Wide-field fundus photograph of an infant:
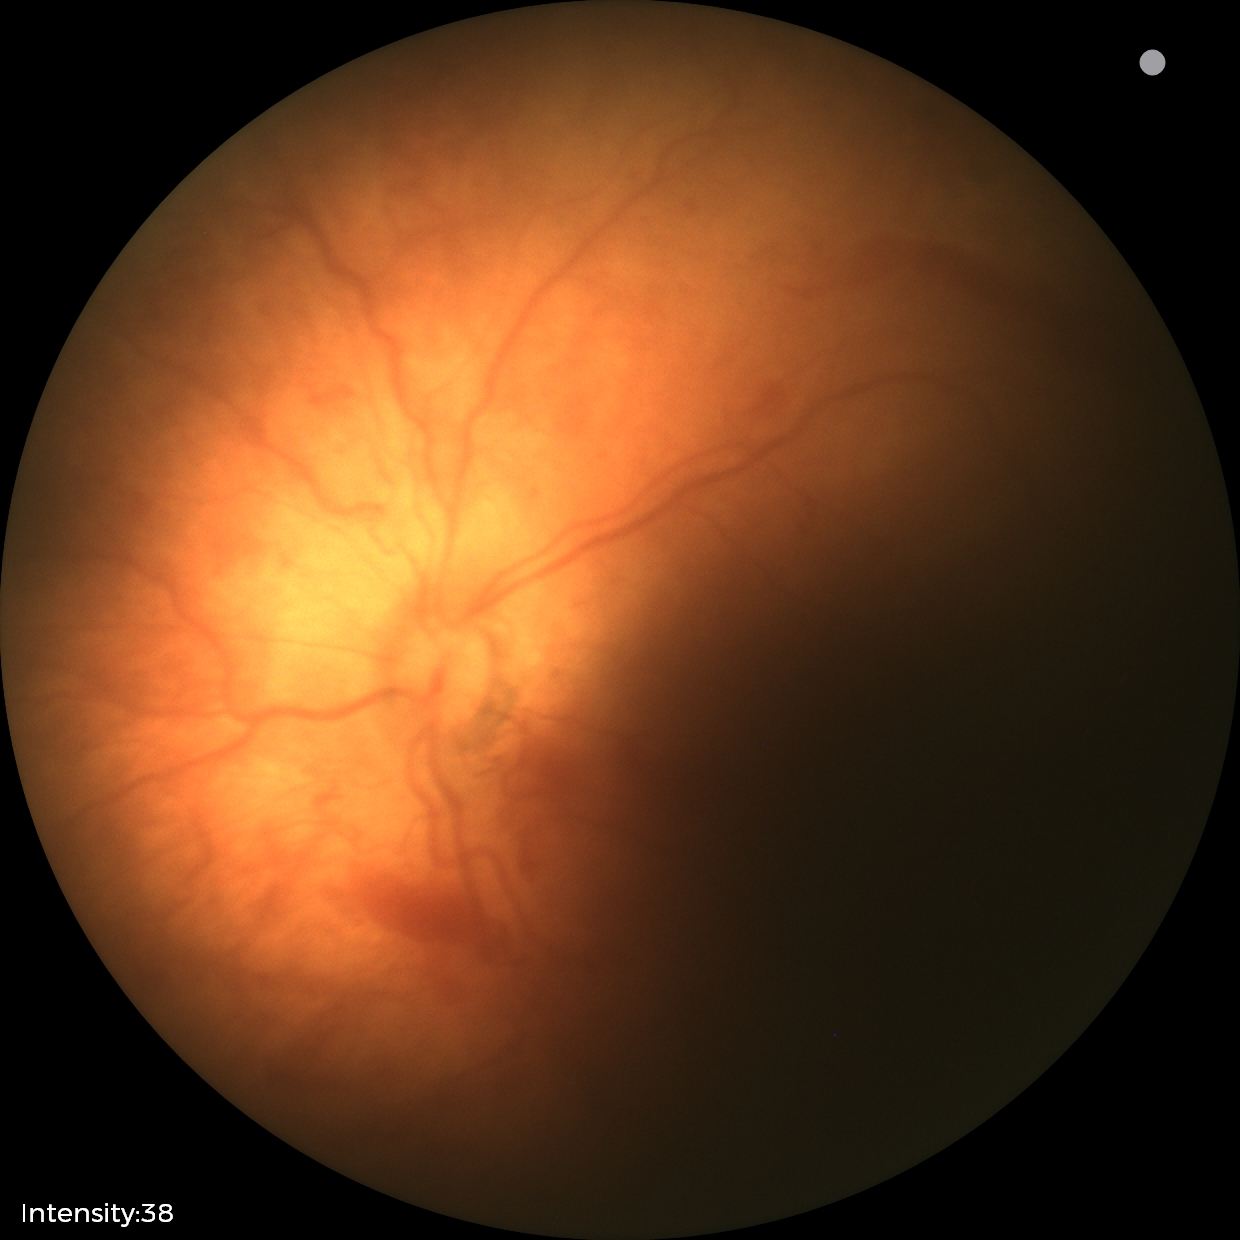

Series diagnosed as status post retinopathy of prematurity (ROP). Without plus disease.